45-degree field of view: 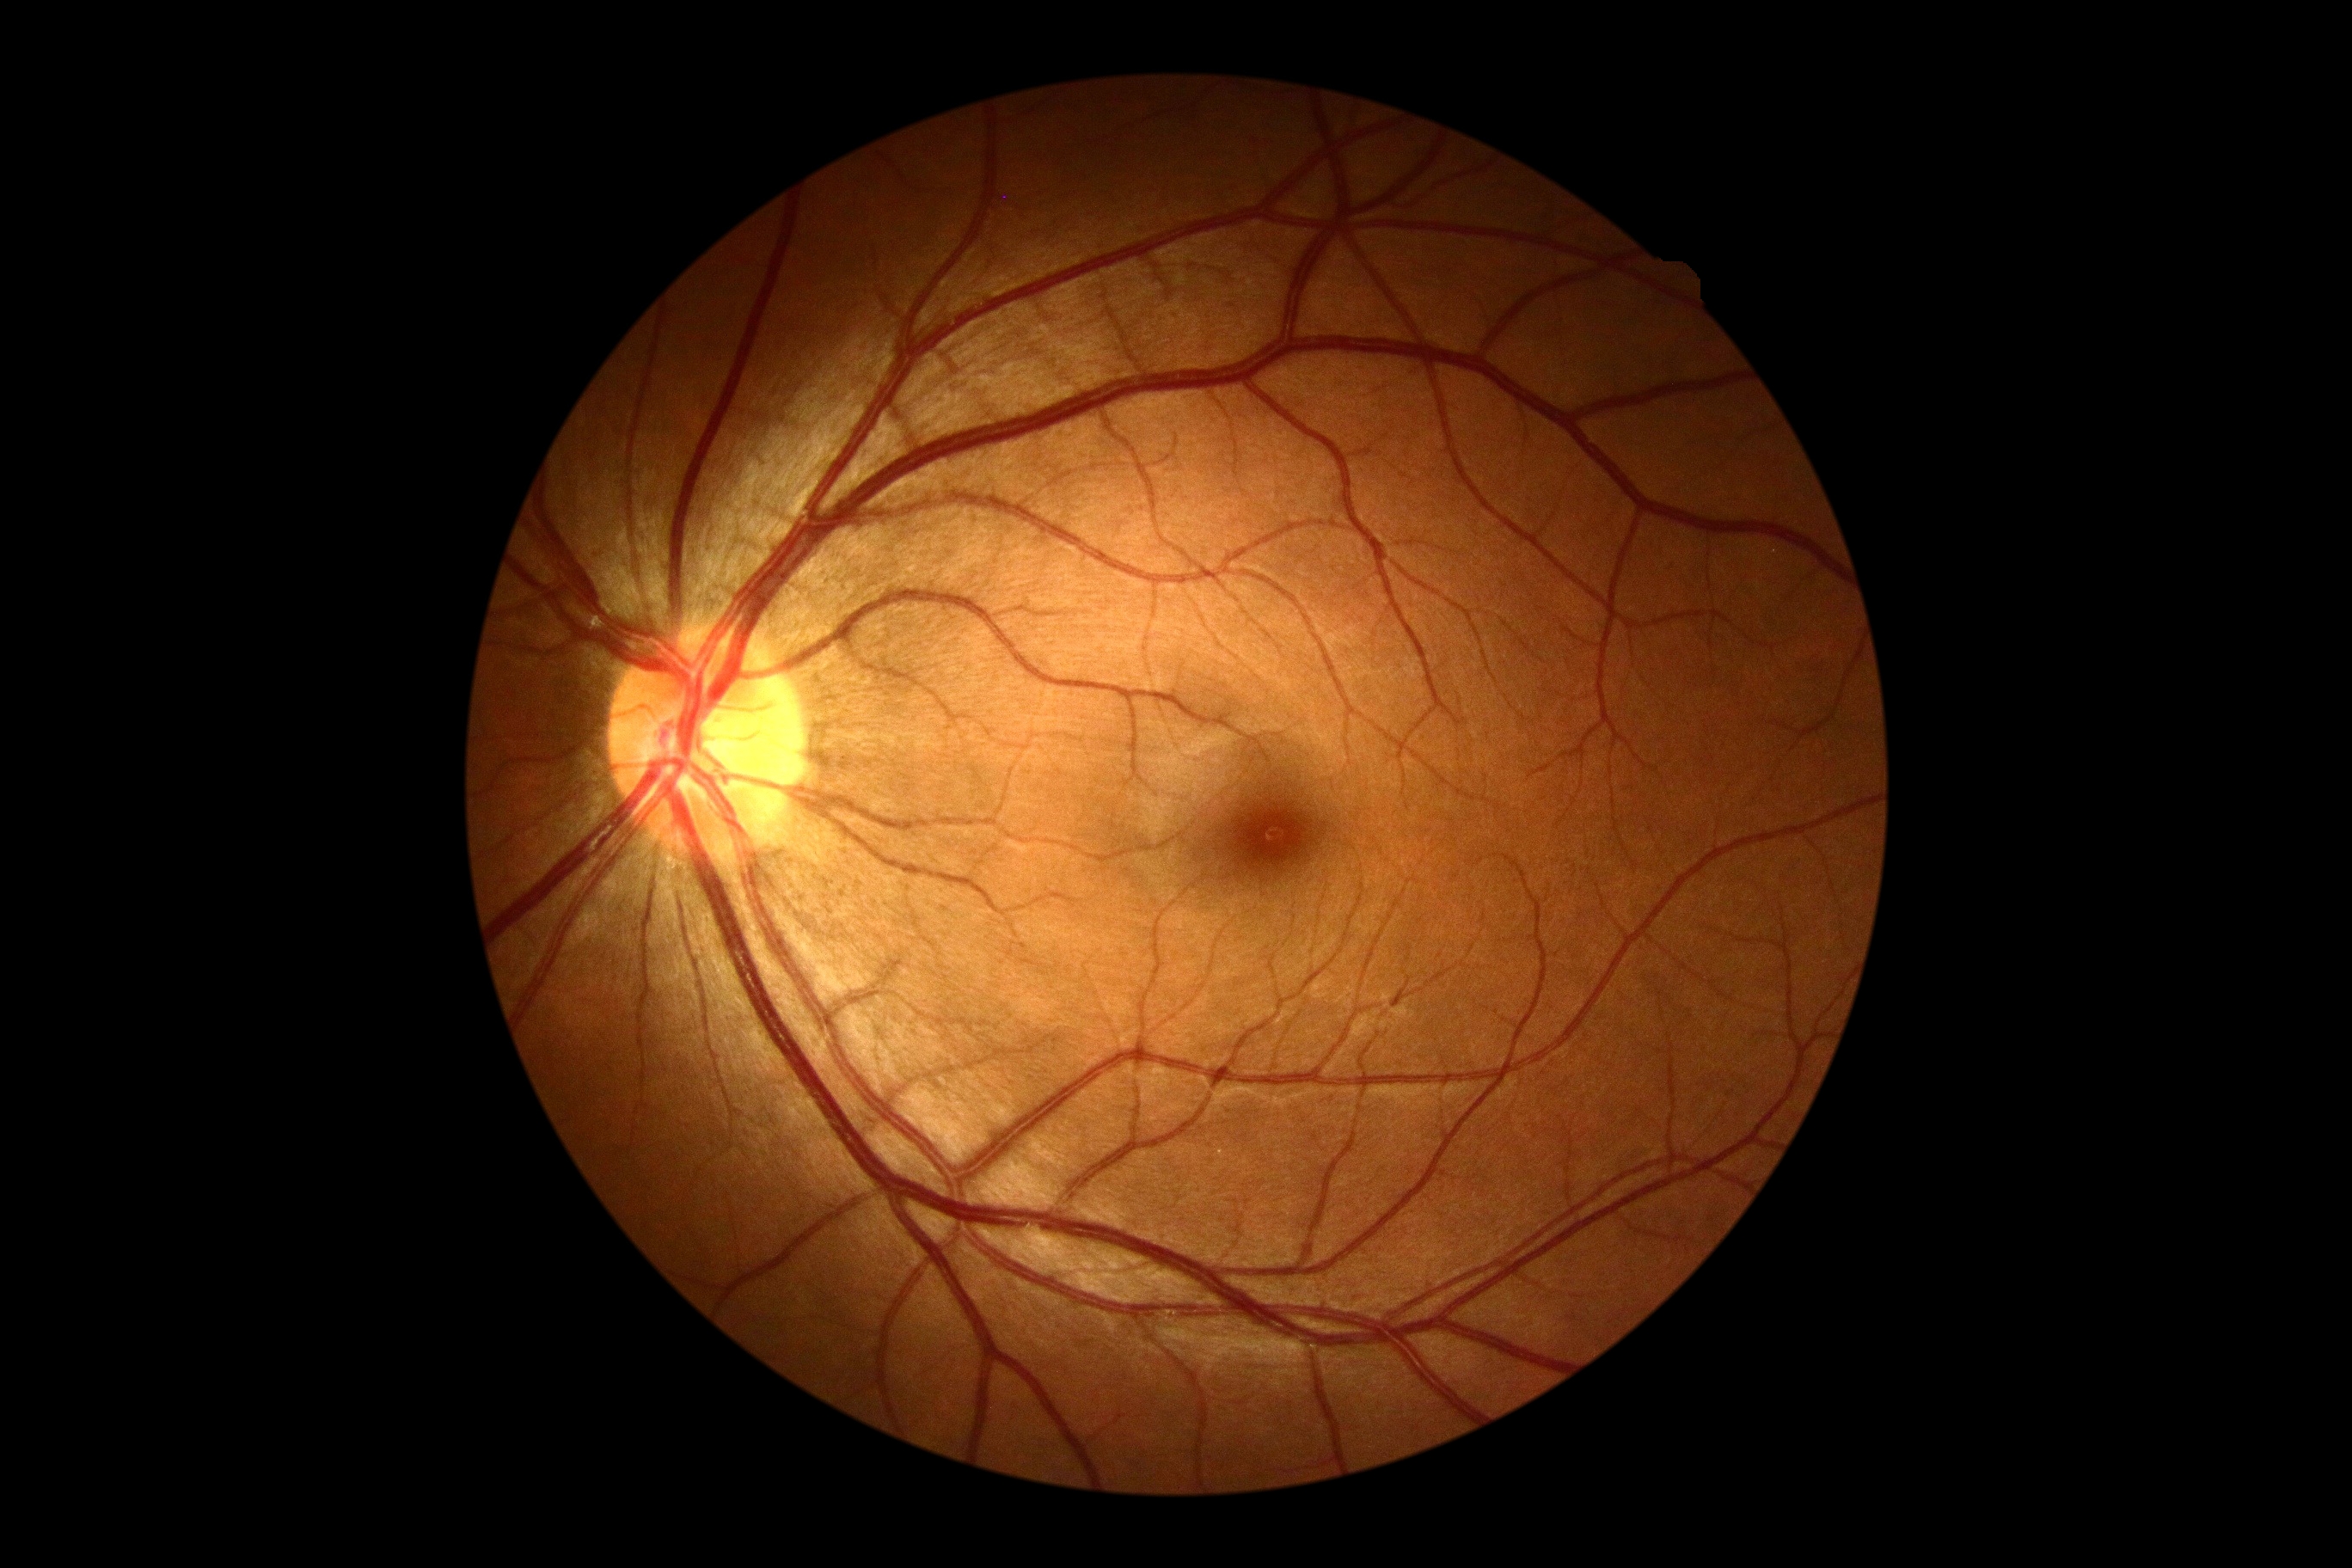 Annotations:
• diabetic retinopathy: grade 0 (no apparent retinopathy)